Dilated-pupil acquisition
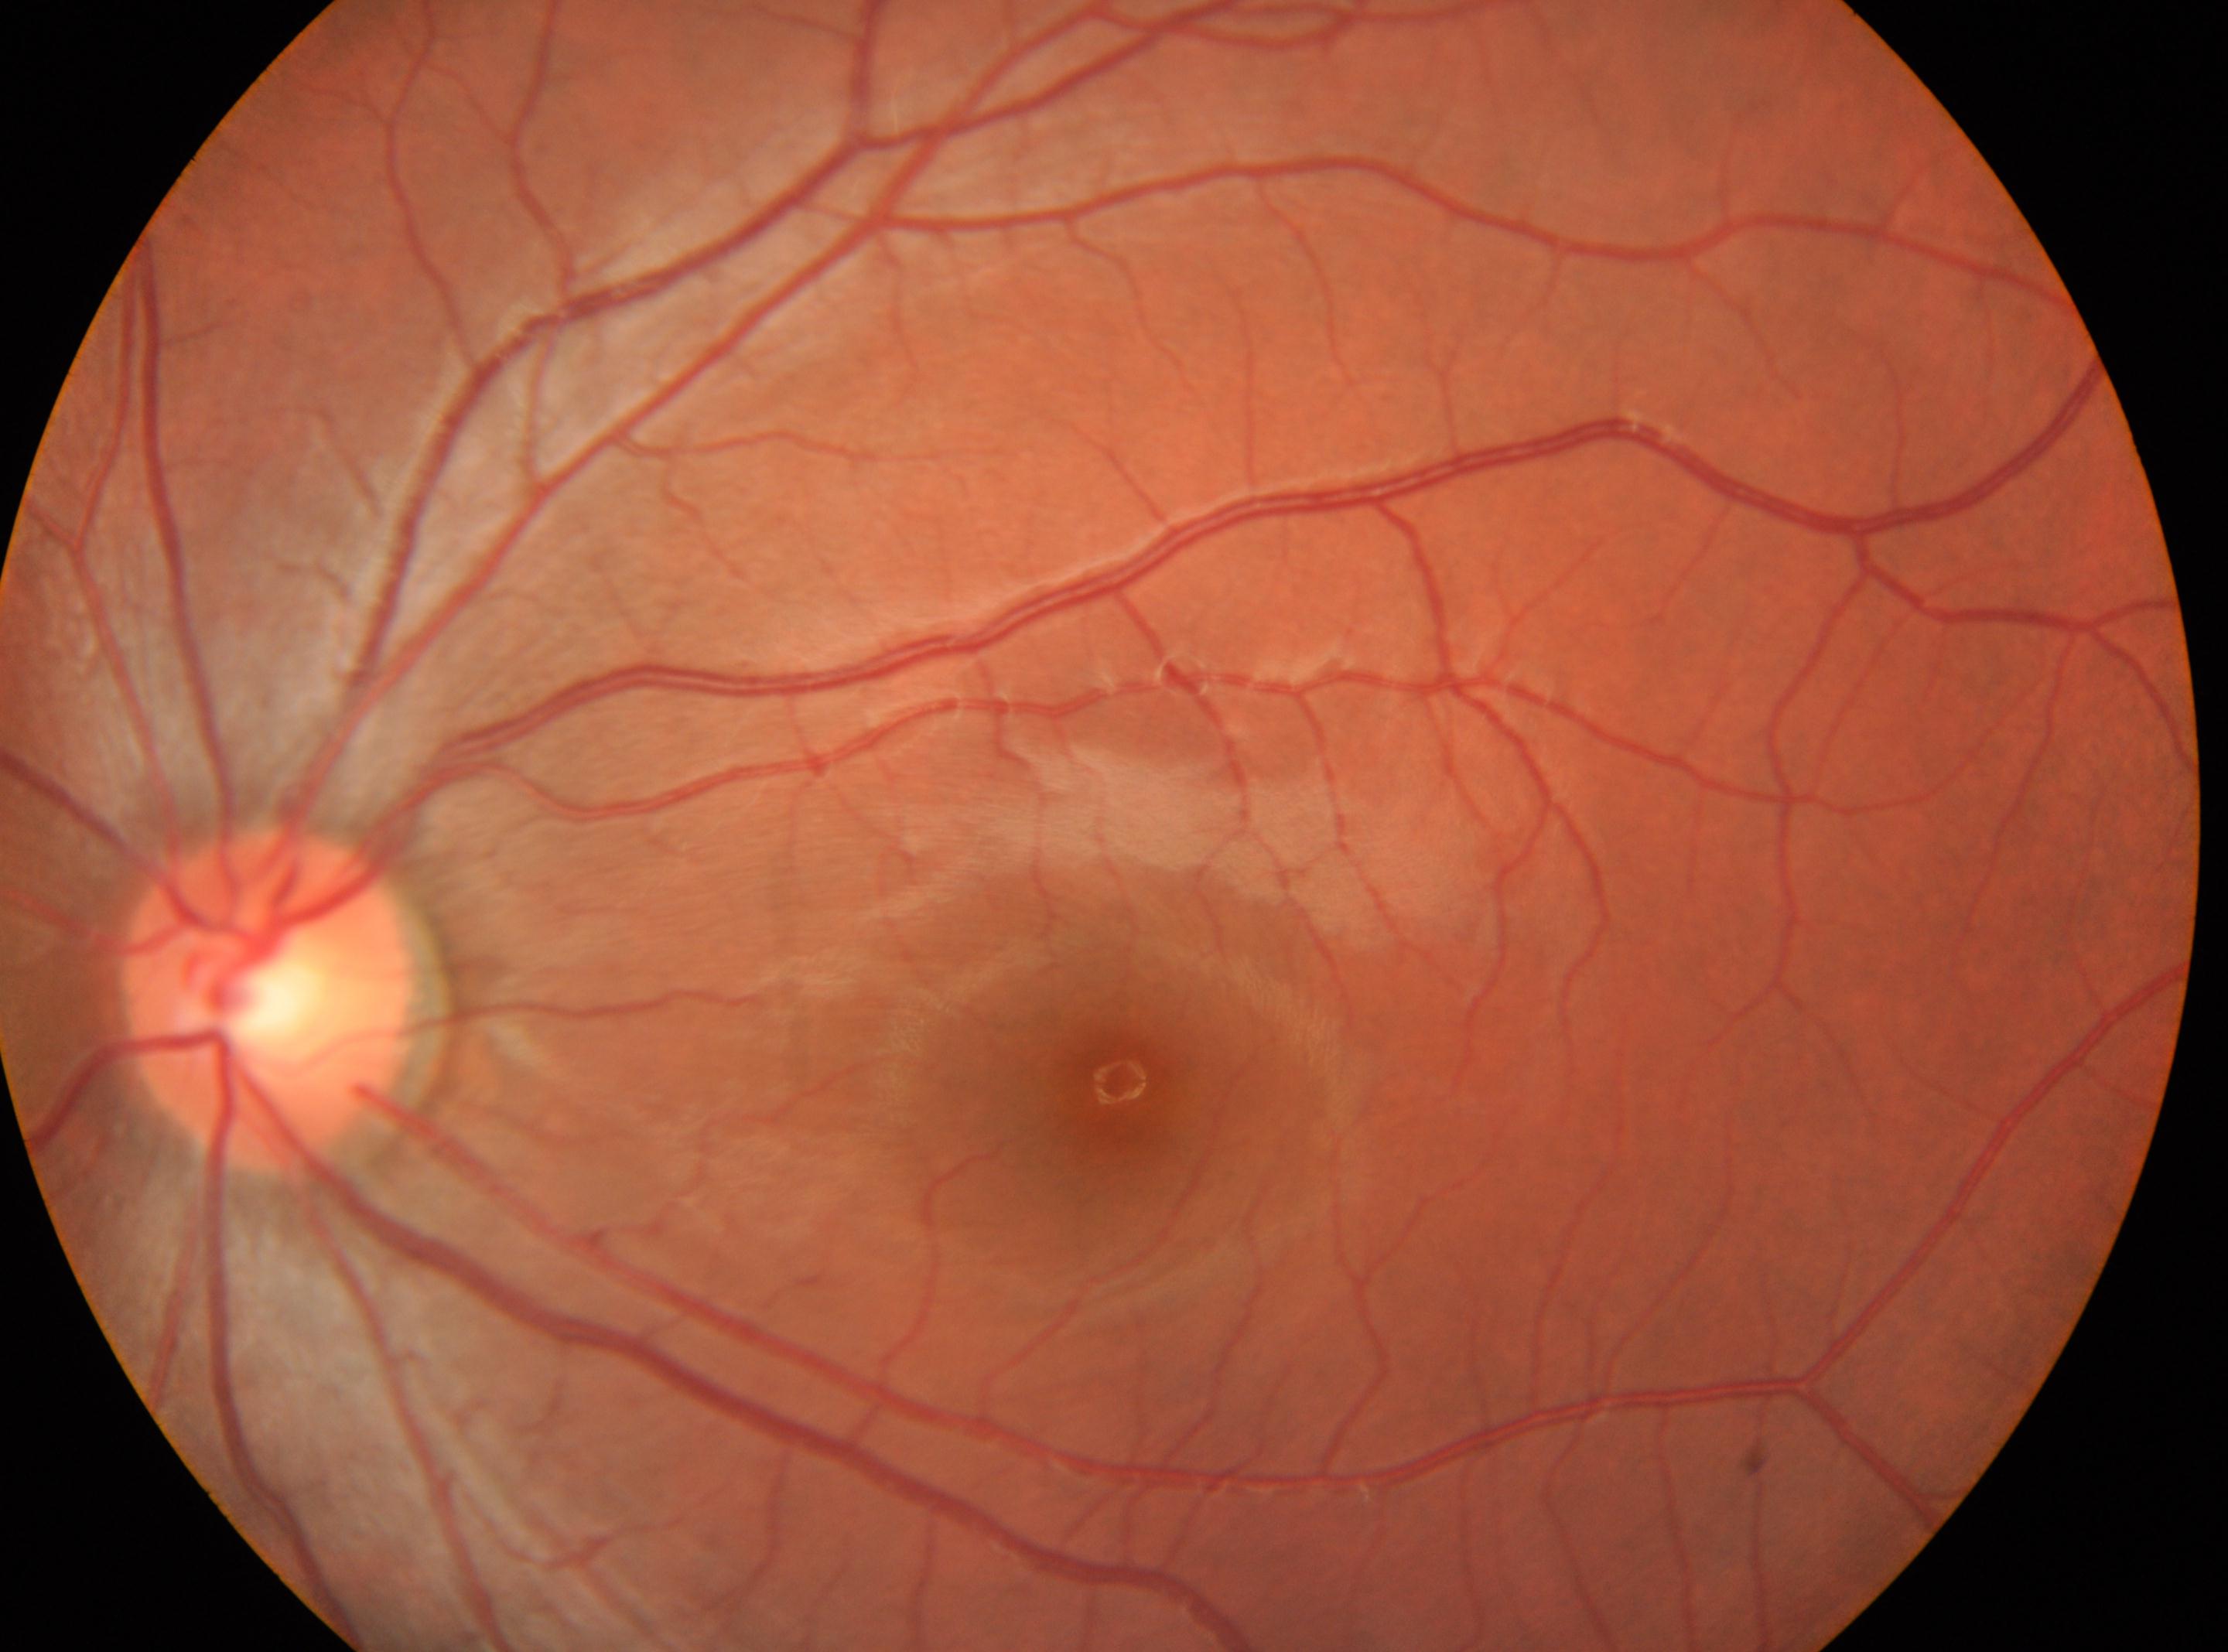
The ONH is at x=270, y=999. No apparent diabetic retinopathy. Retinopathy grade is 0/4 — no visible signs of diabetic retinopathy. Fovea center located at x=1117, y=1091. This is the left eye.